Color fundus photograph — 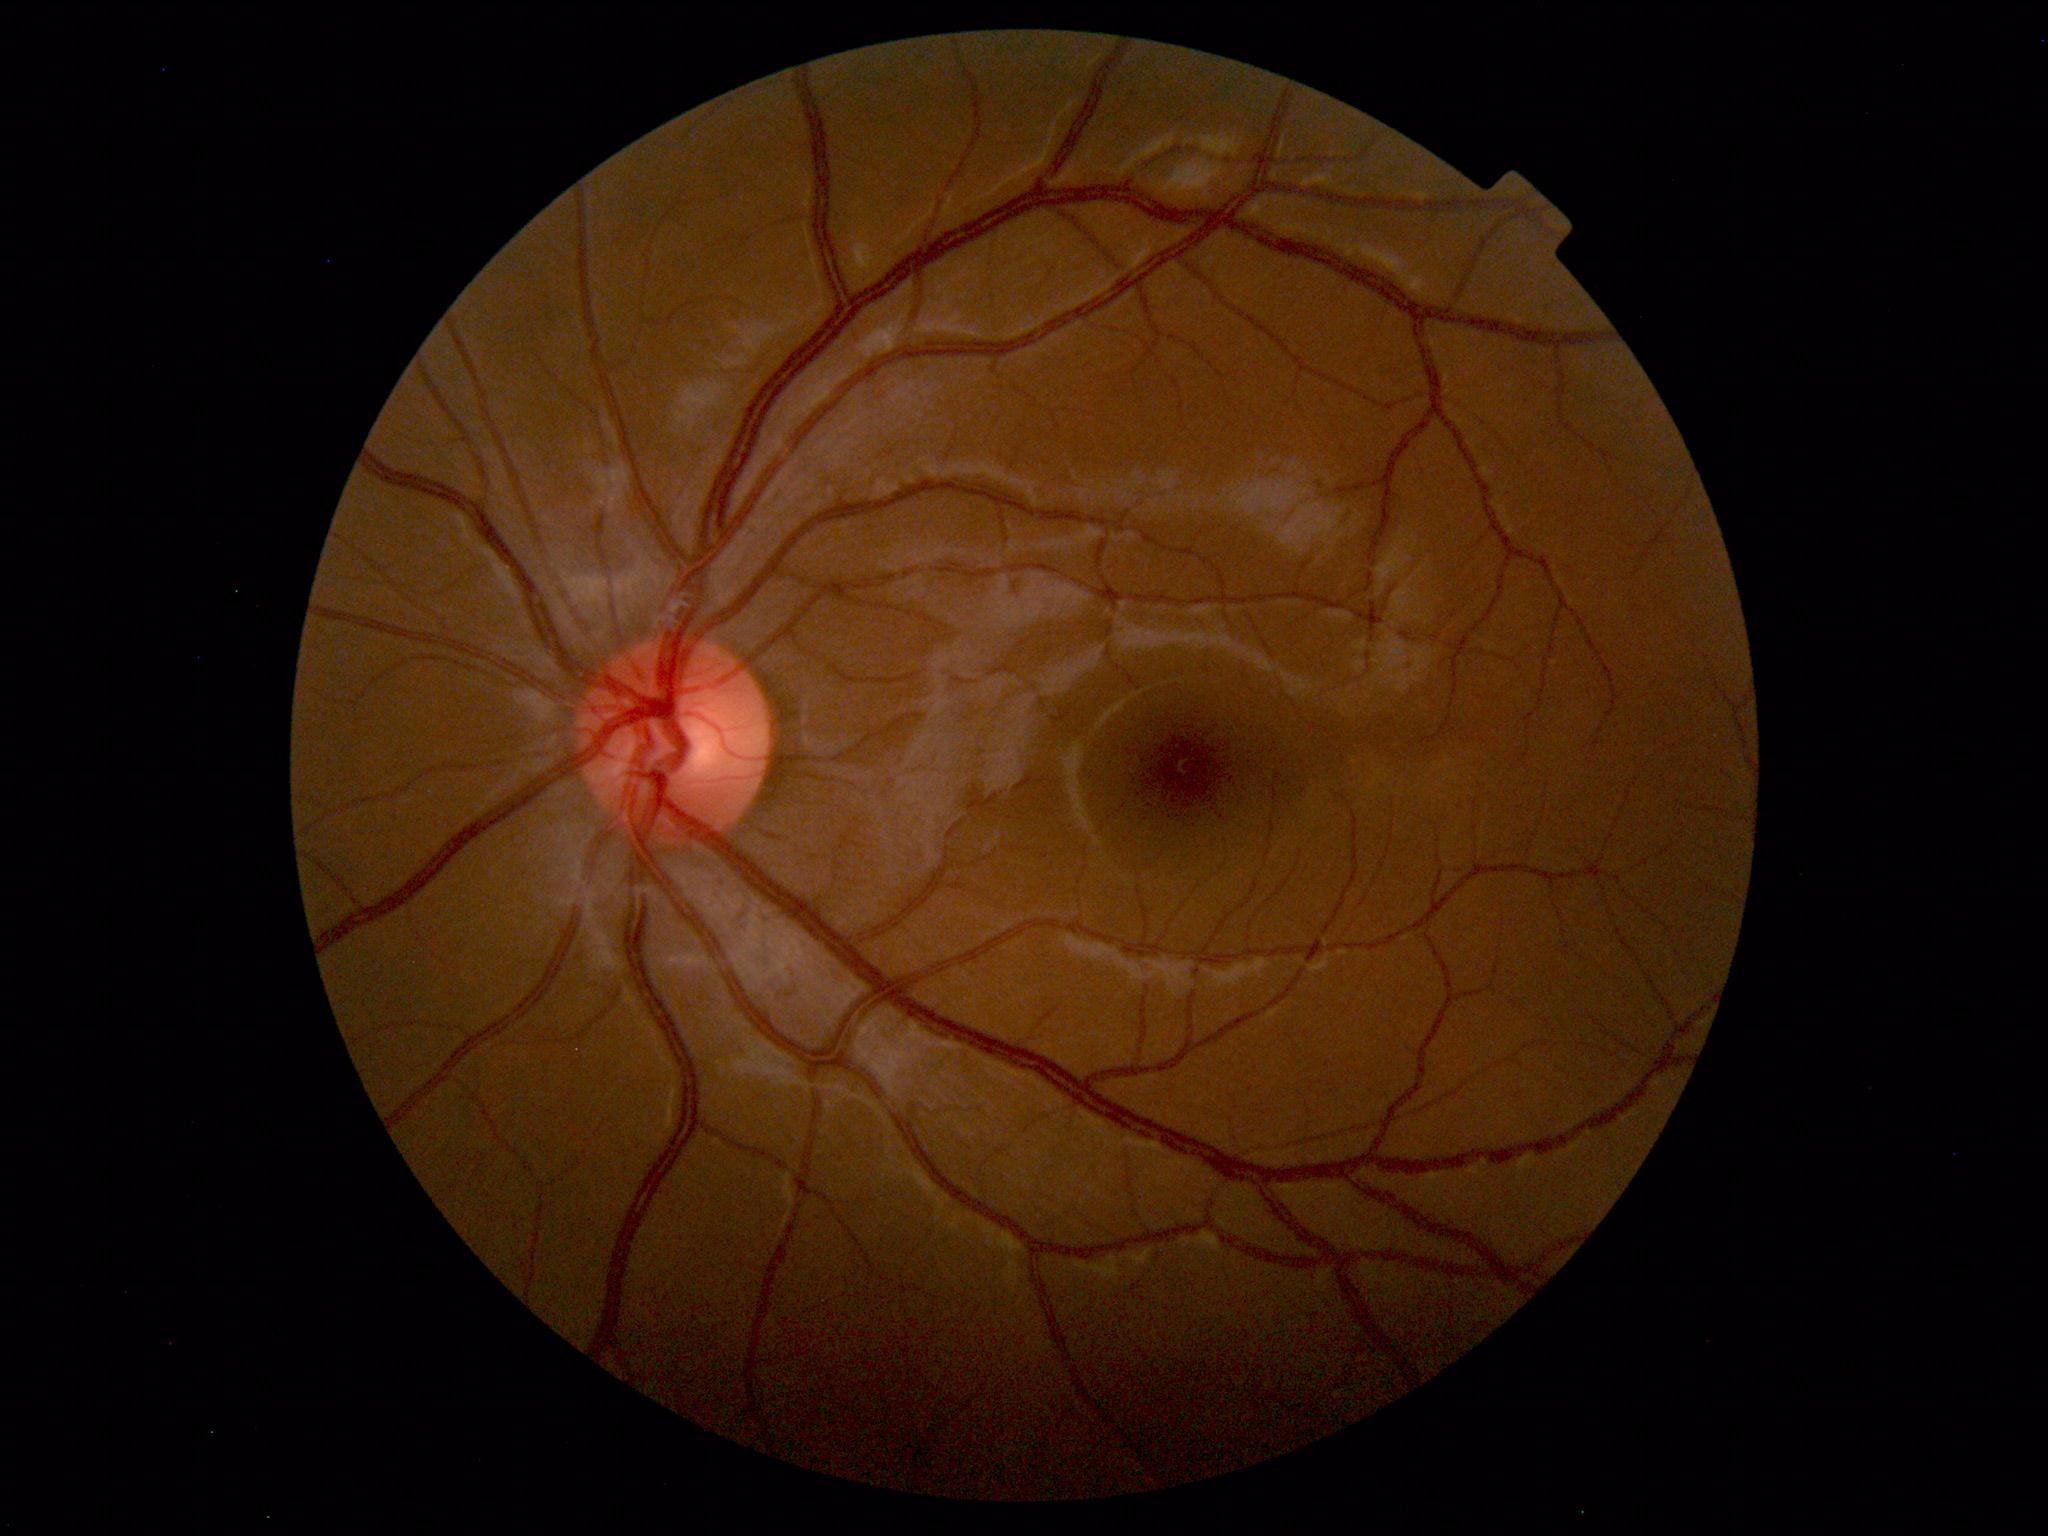 Normal fundus appearance.